1960 x 1897 pixels, 45° field of view.
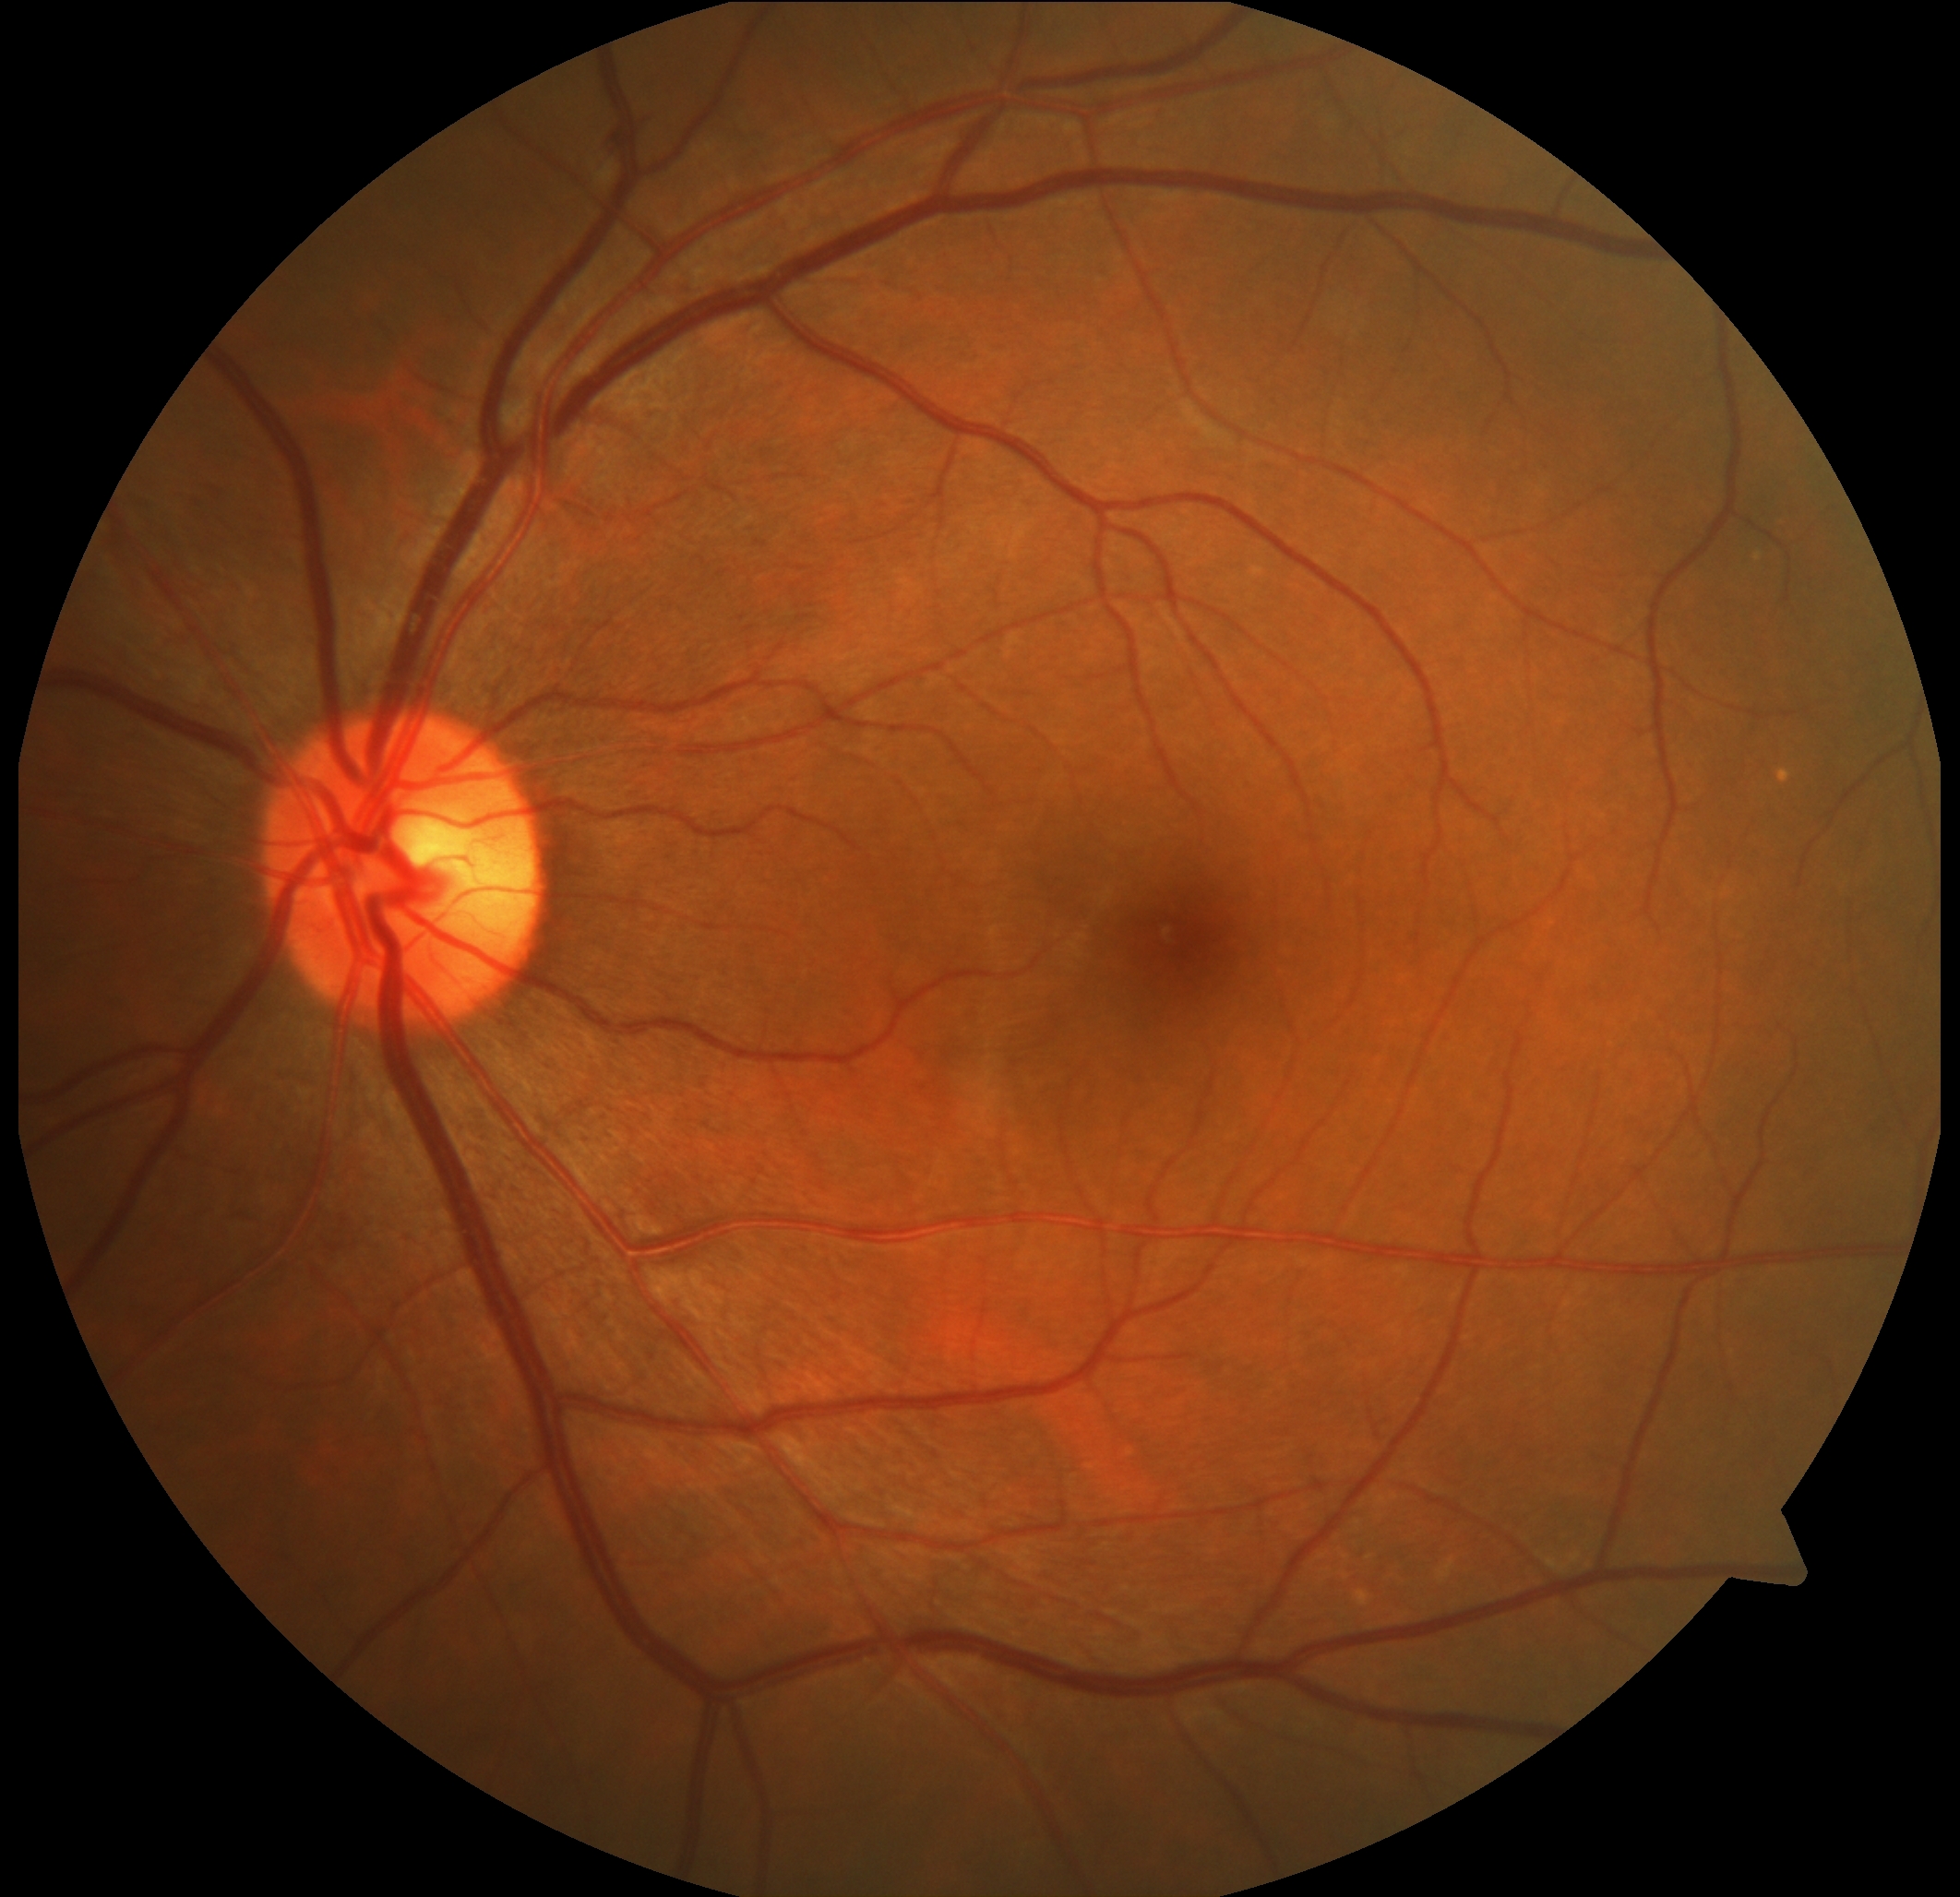 diabetic retinopathy (DR): grade 2 (moderate NPDR); DR class: non-proliferative diabetic retinopathy.